Davis DR grading:
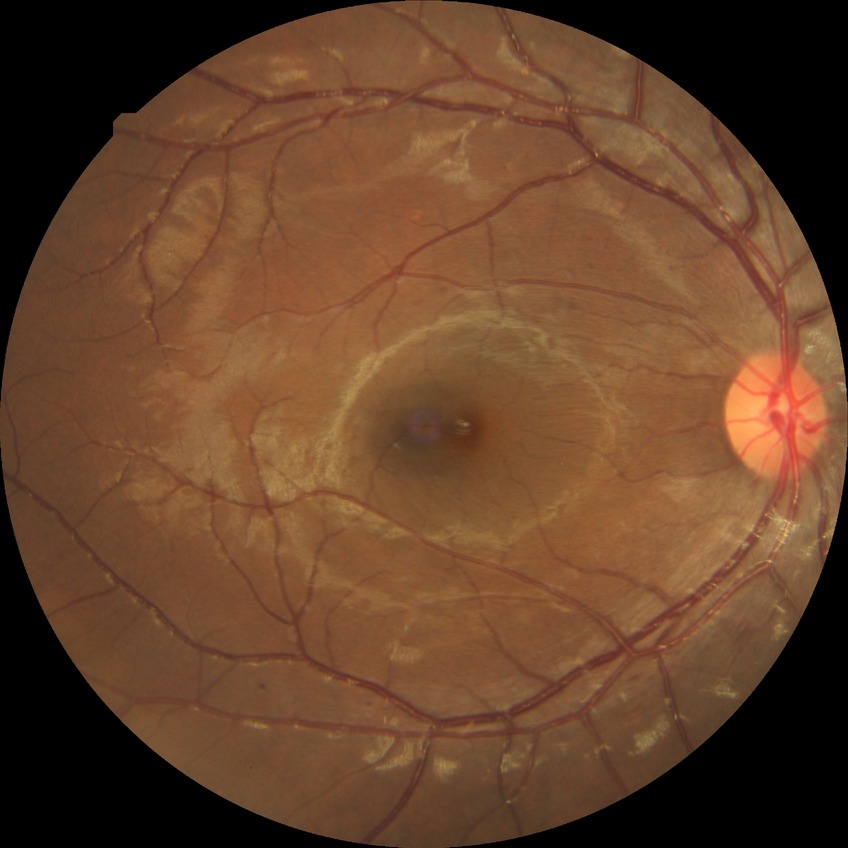

{
  "davis_grade": "simple diabetic retinopathy"
}